640 by 480 pixels · infant wide-field retinal image — 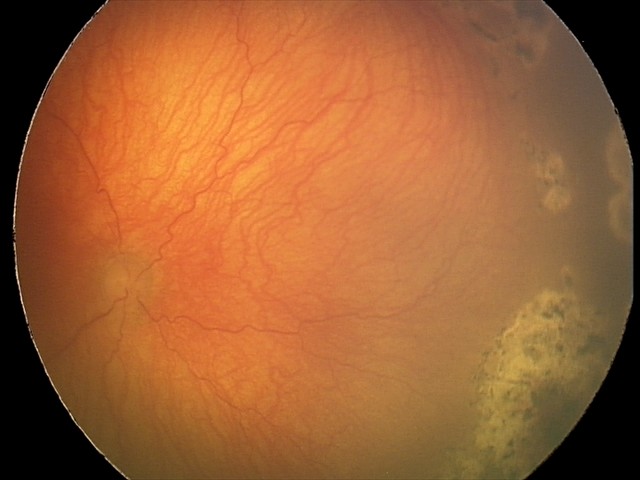

Plus disease = present | diagnosis = aggressive ROP (A-ROP).